DR severity per modified Davis staging, color fundus photograph, 848 by 848 pixels.
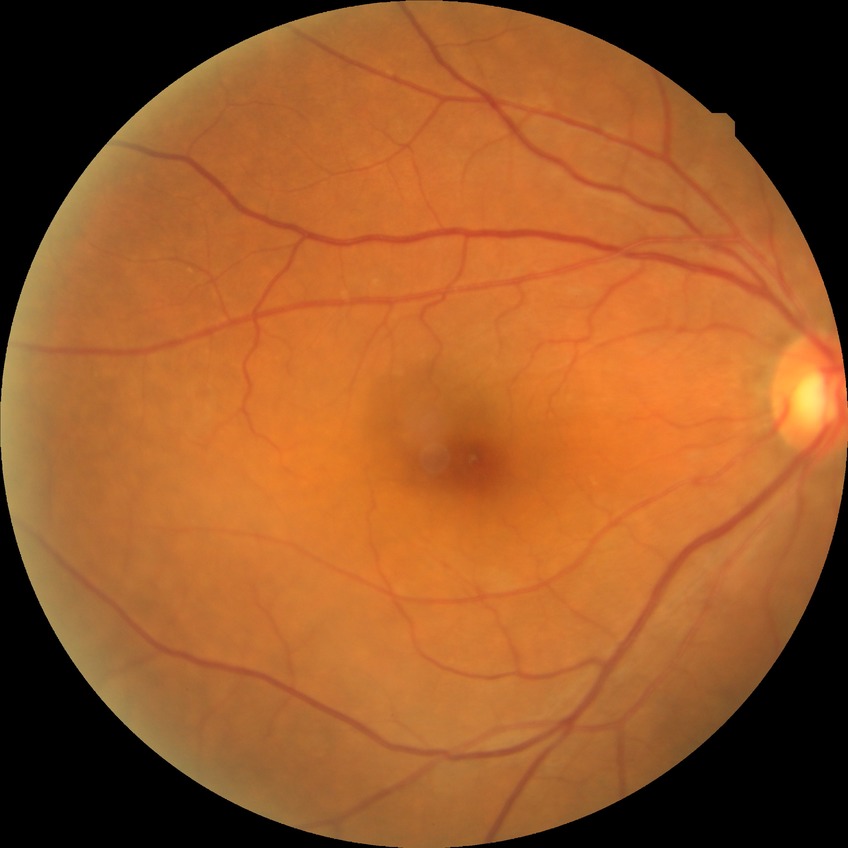 Diabetic retinopathy stage is no diabetic retinopathy.